Handheld portable fundus camera image: 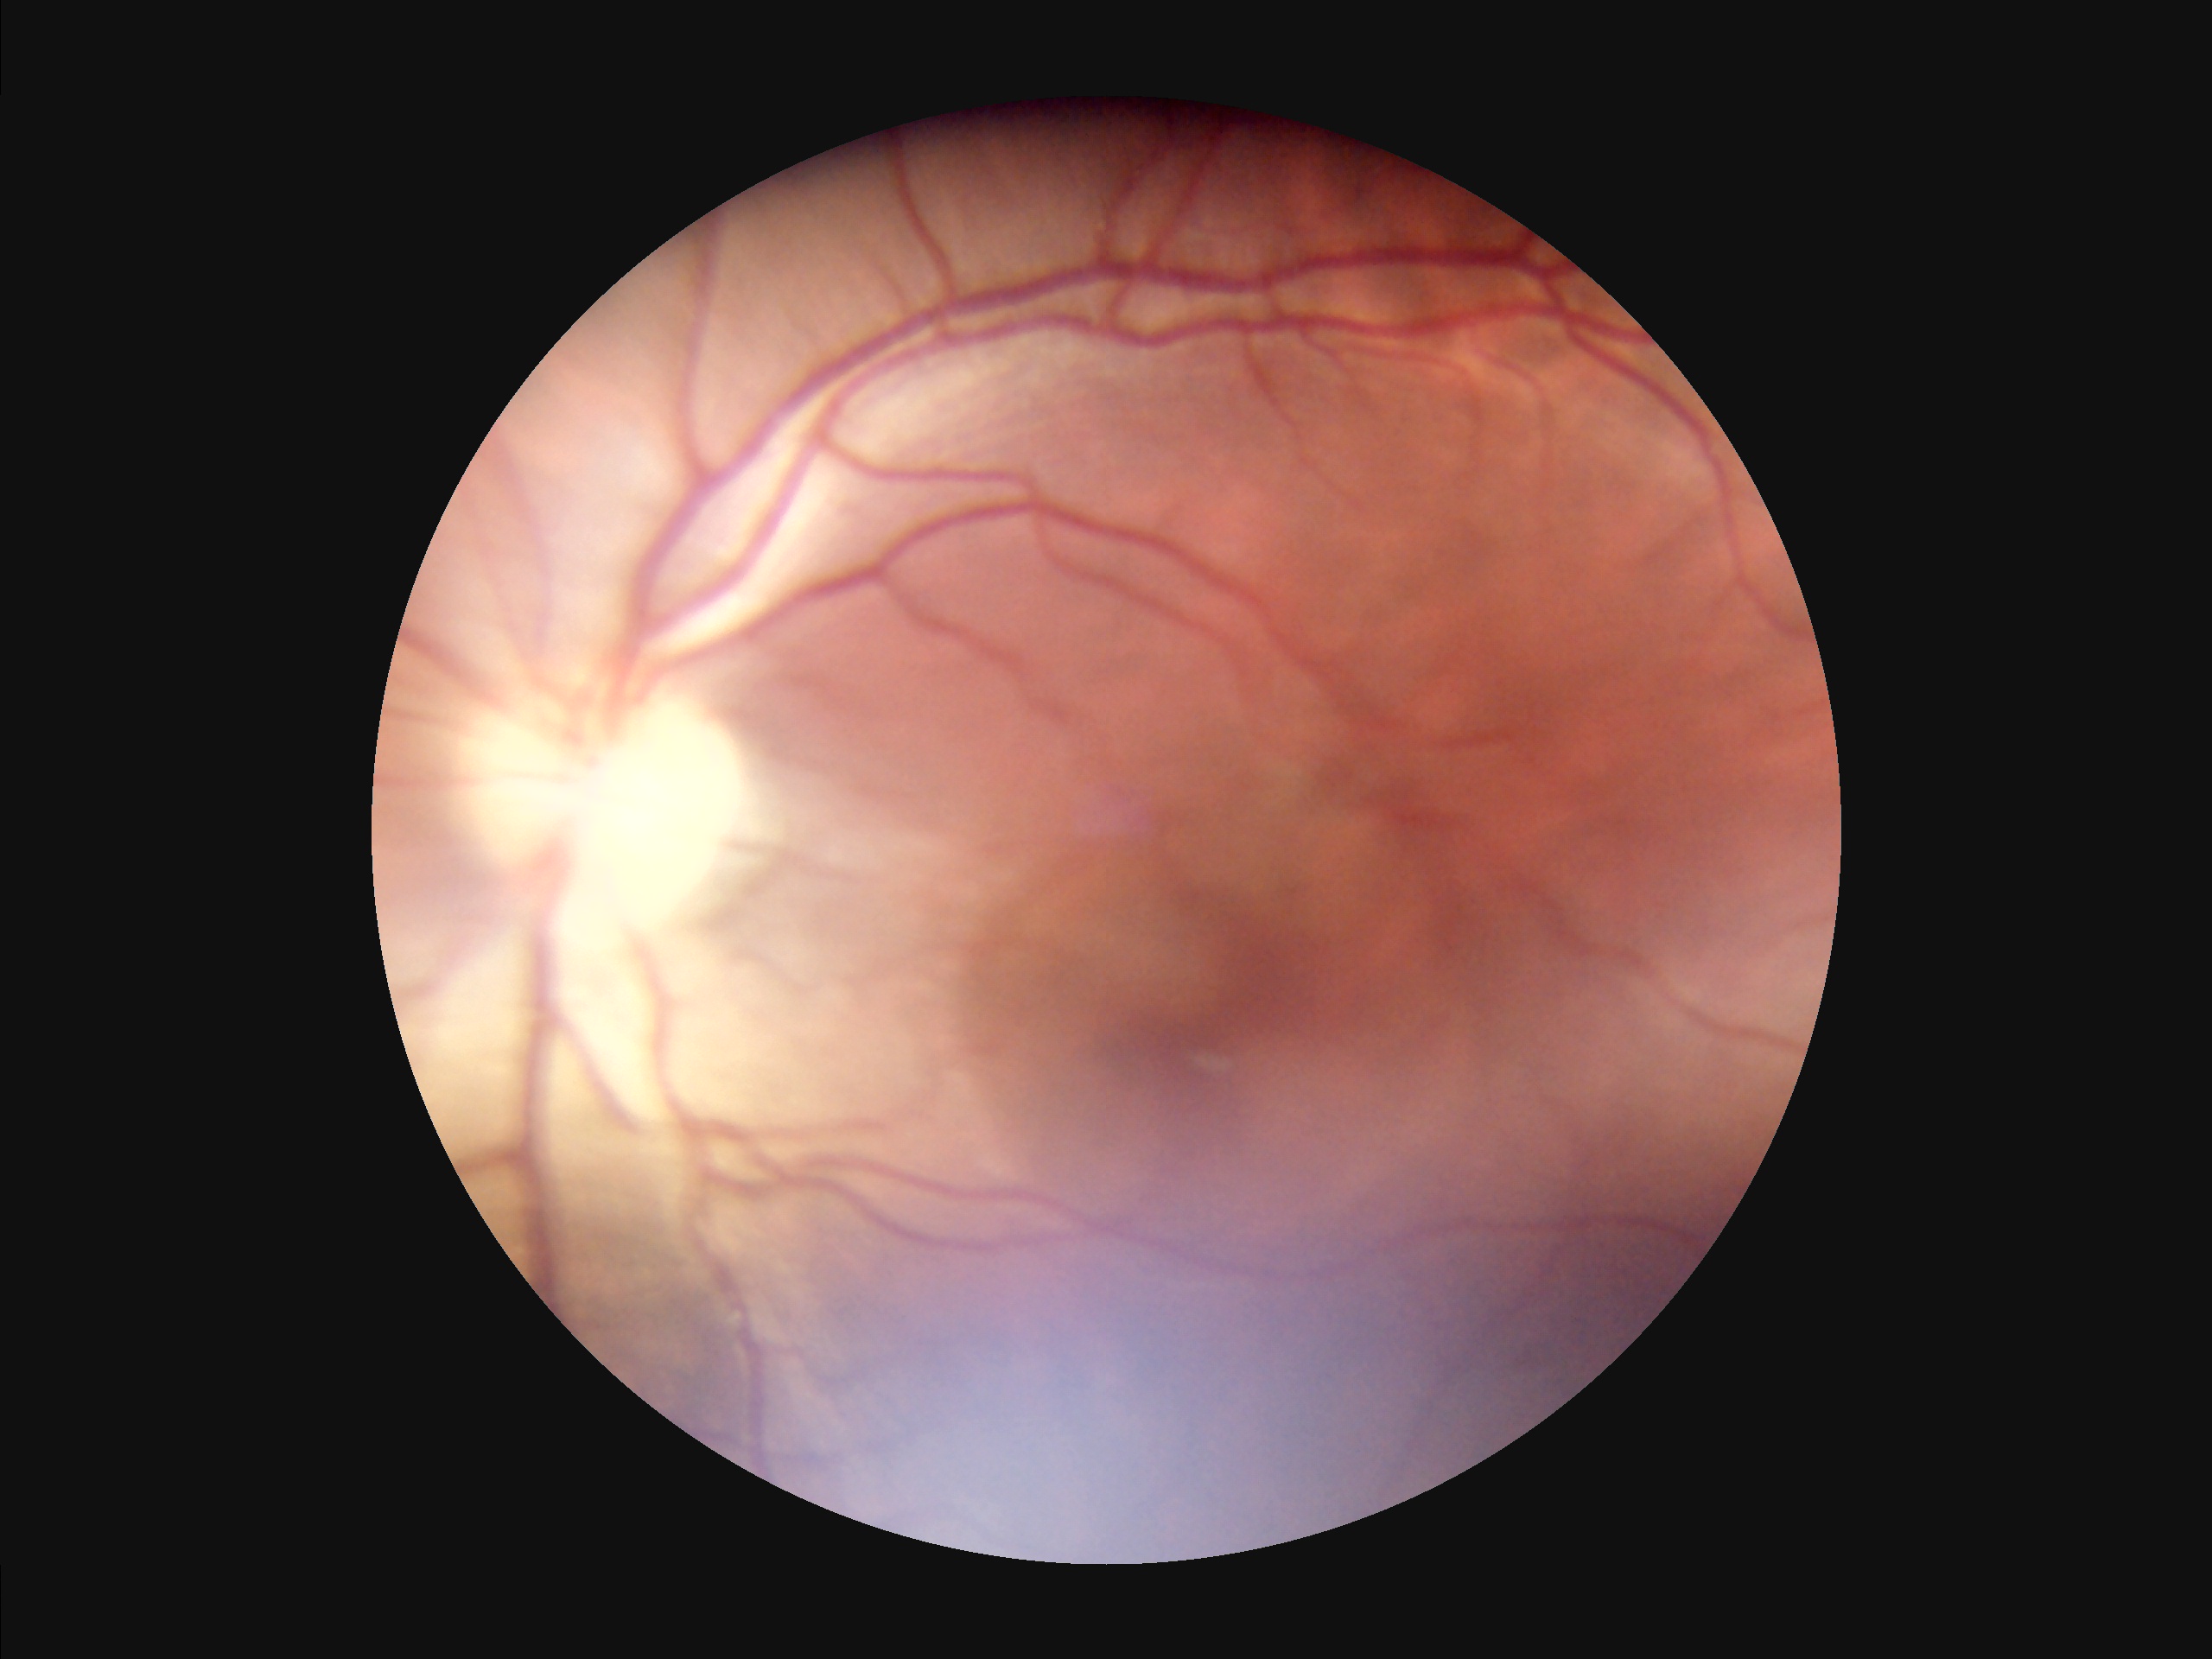

Vessels and details are readily distinguishable.
Noticeable blur in the optic disc, vessels, or background.
Illumination is uneven.
Image quality is suboptimal.